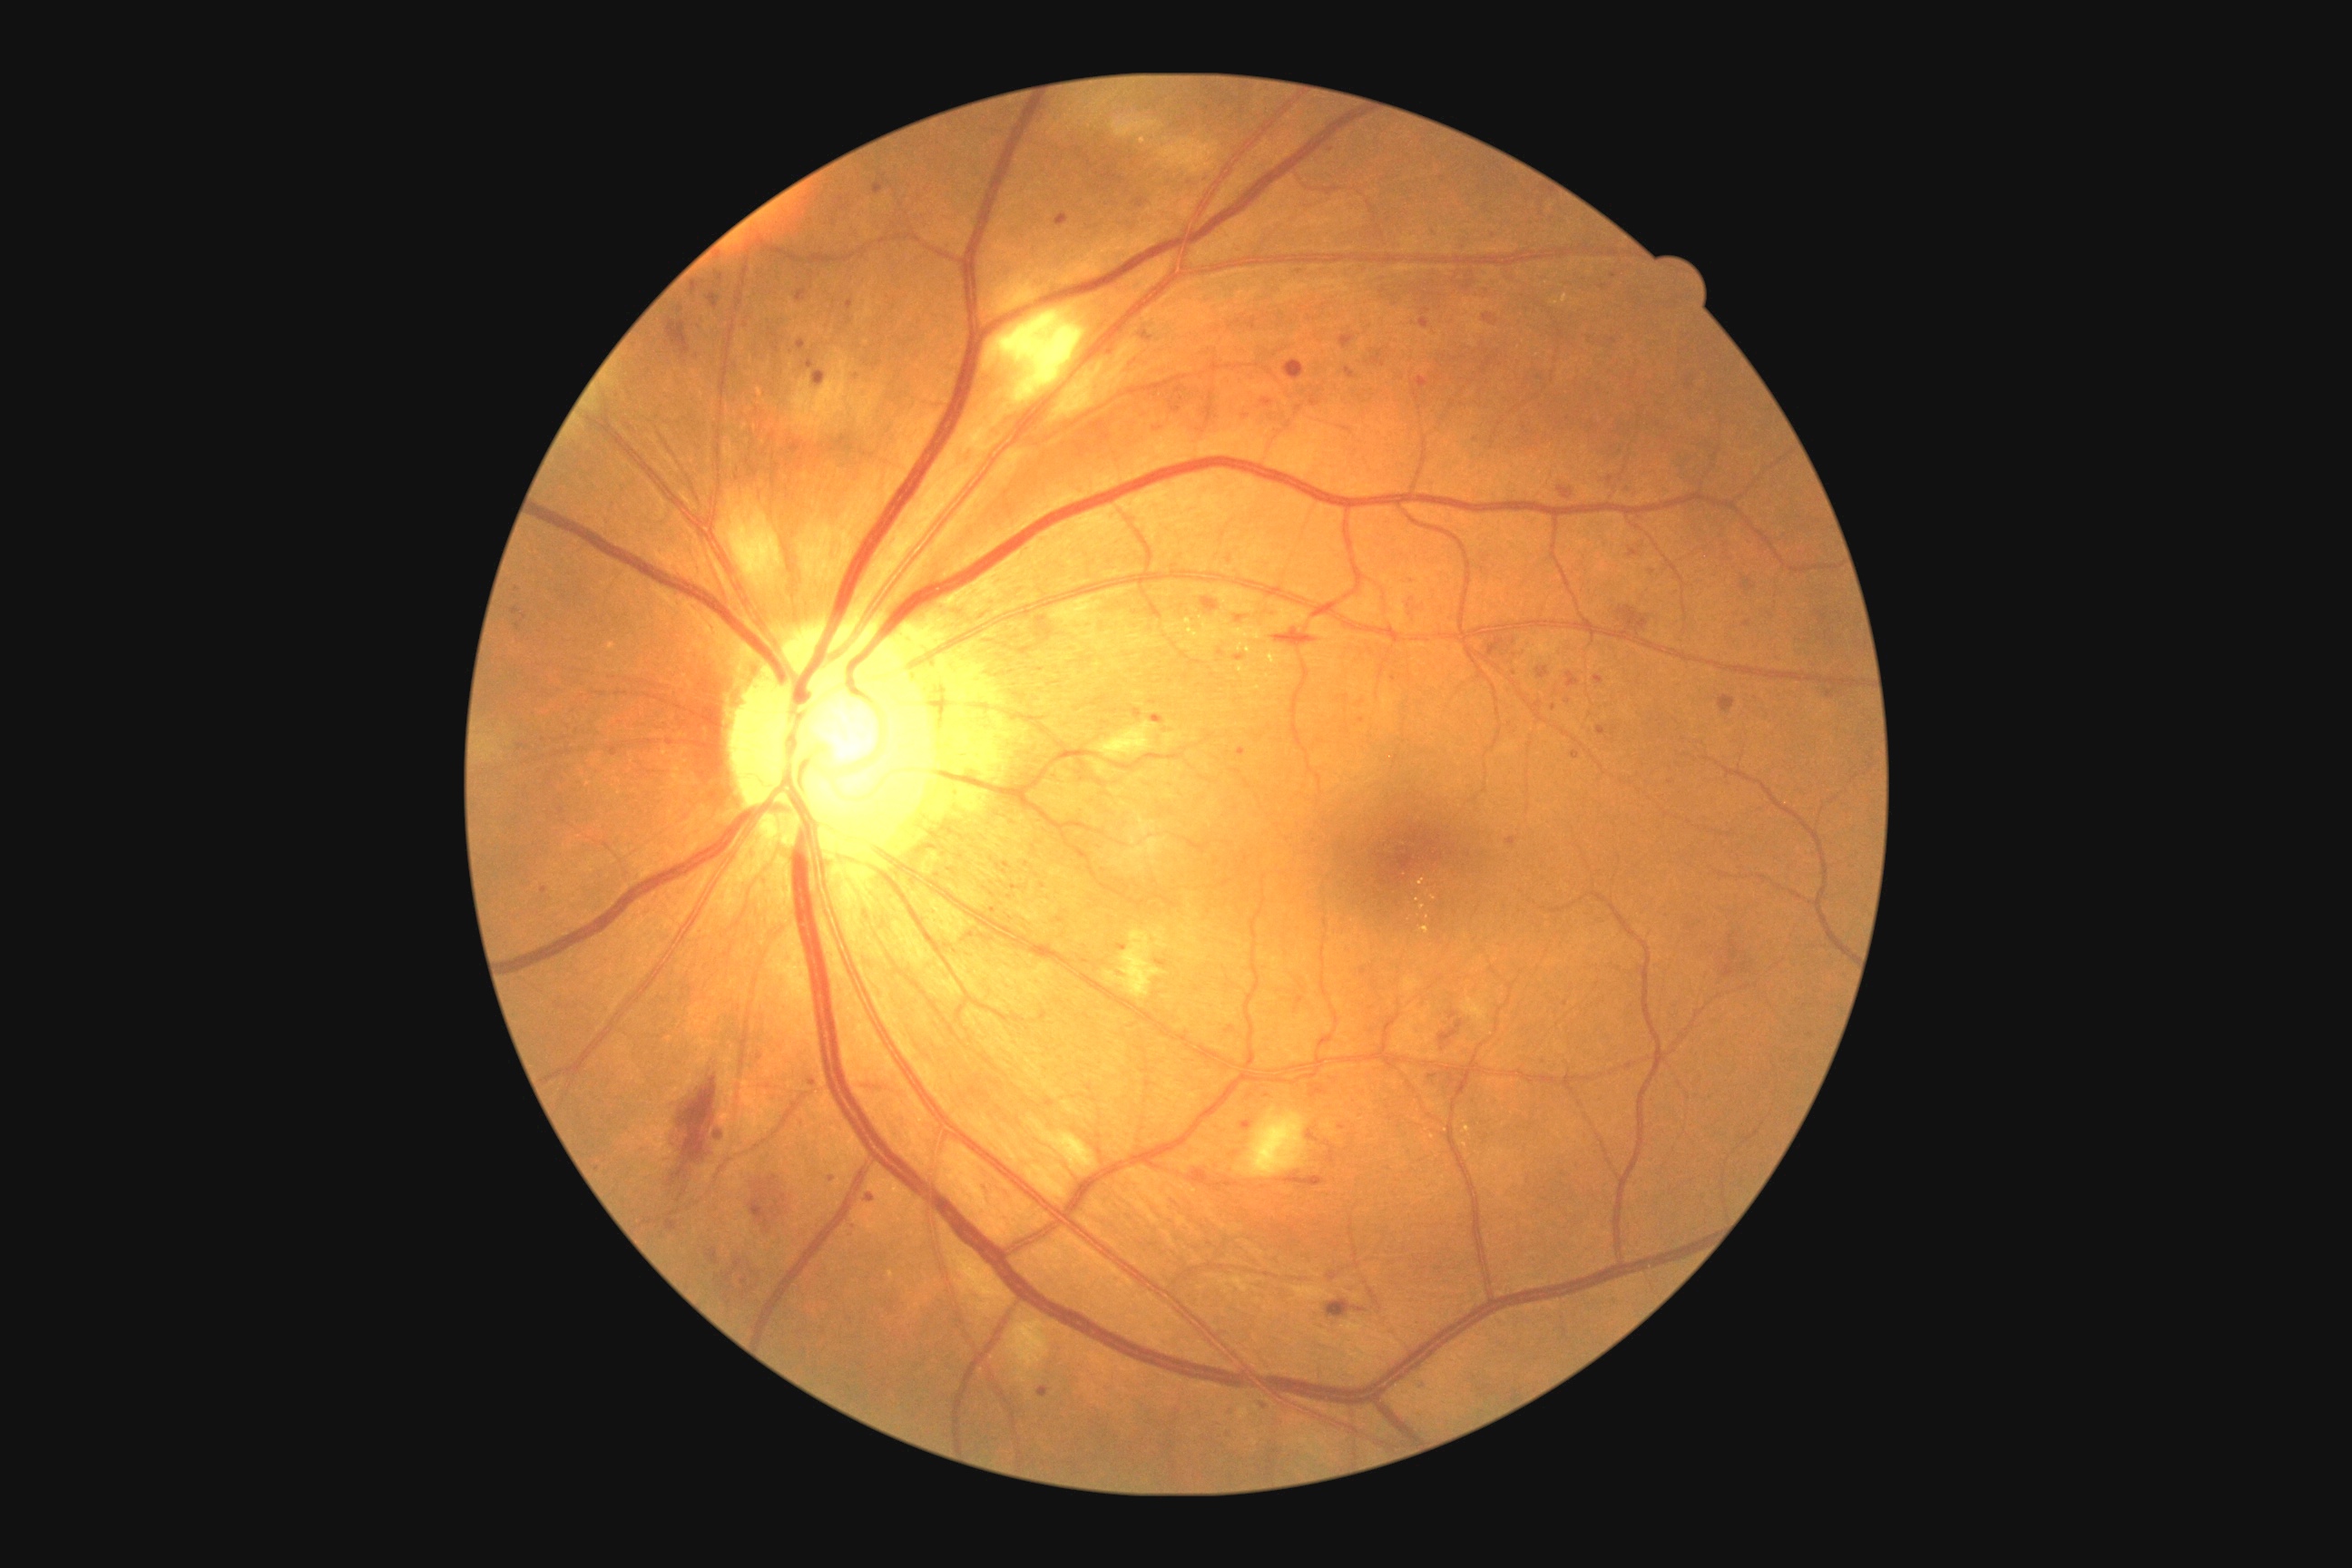

Diabetic retinopathy grade is 2/4
Lesions identified (partial list):
microaneurysms (continued): 1260:400:1273:407 | 522:614:527:622 | 609:747:618:758 | 865:1195:876:1202 | 1565:672:1582:687 | 1226:1026:1235:1034 | 814:371:827:387 | 1536:667:1551:680 | 1242:1121:1253:1132 | 1594:674:1603:685 | 1338:1124:1346:1130 | 1037:1387:1050:1398 | 540:888:547:896
Microaneurysms (small, approximate centers) near (x=1604, y=288) | (x=759, y=1058) | (x=1346, y=730) | (x=1300, y=273) | (x=1040, y=635) | (x=1615, y=732)